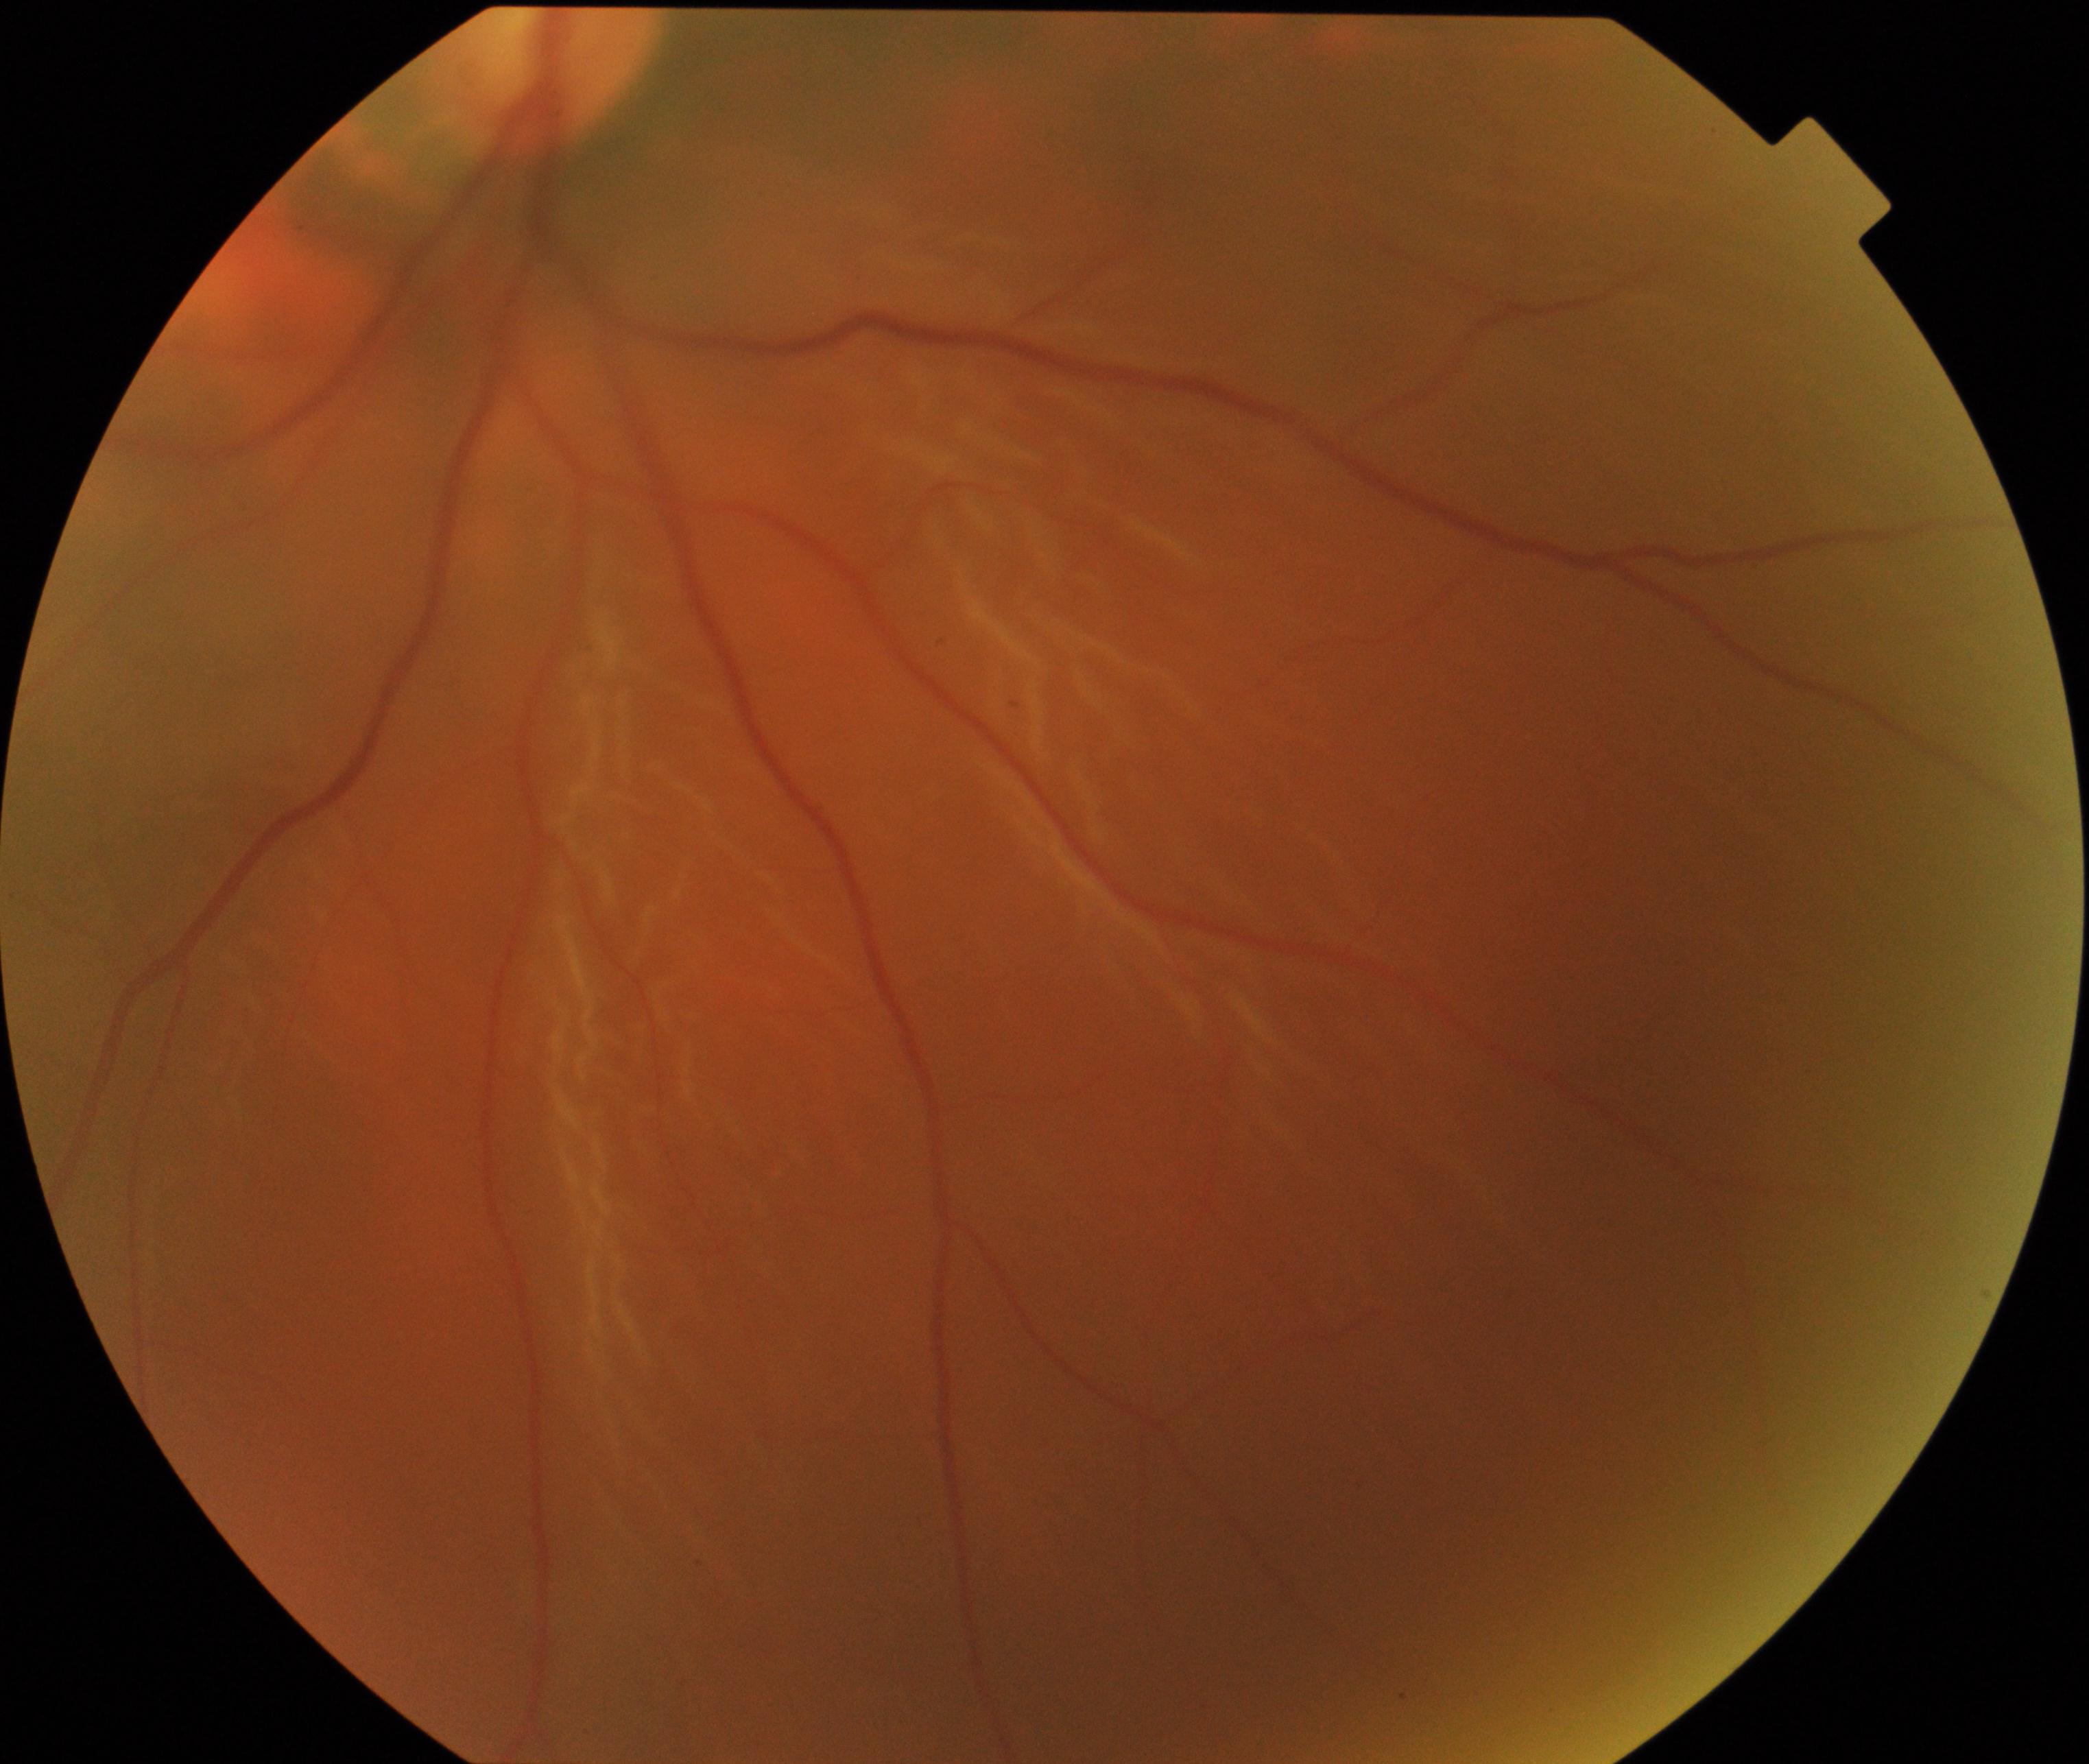 Appearance consistent with rhegmatogenous retinal detachment.